Acquired with a NIDEK AFC-230:
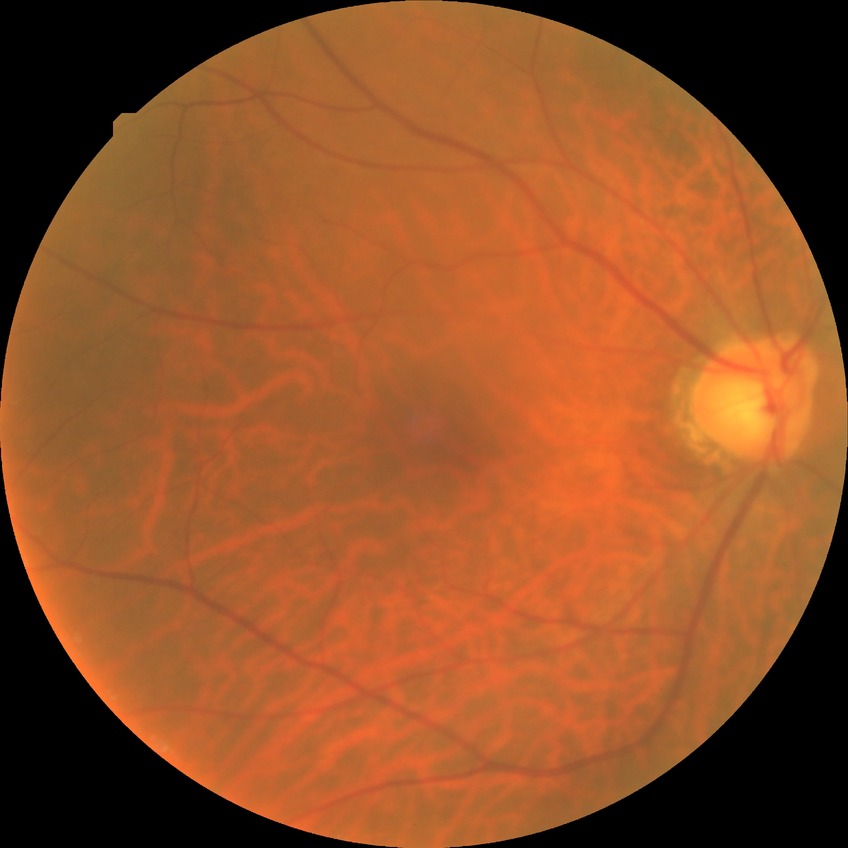
Diabetic retinopathy grade is no diabetic retinopathy.